45° field of view, image size 1932x1916: 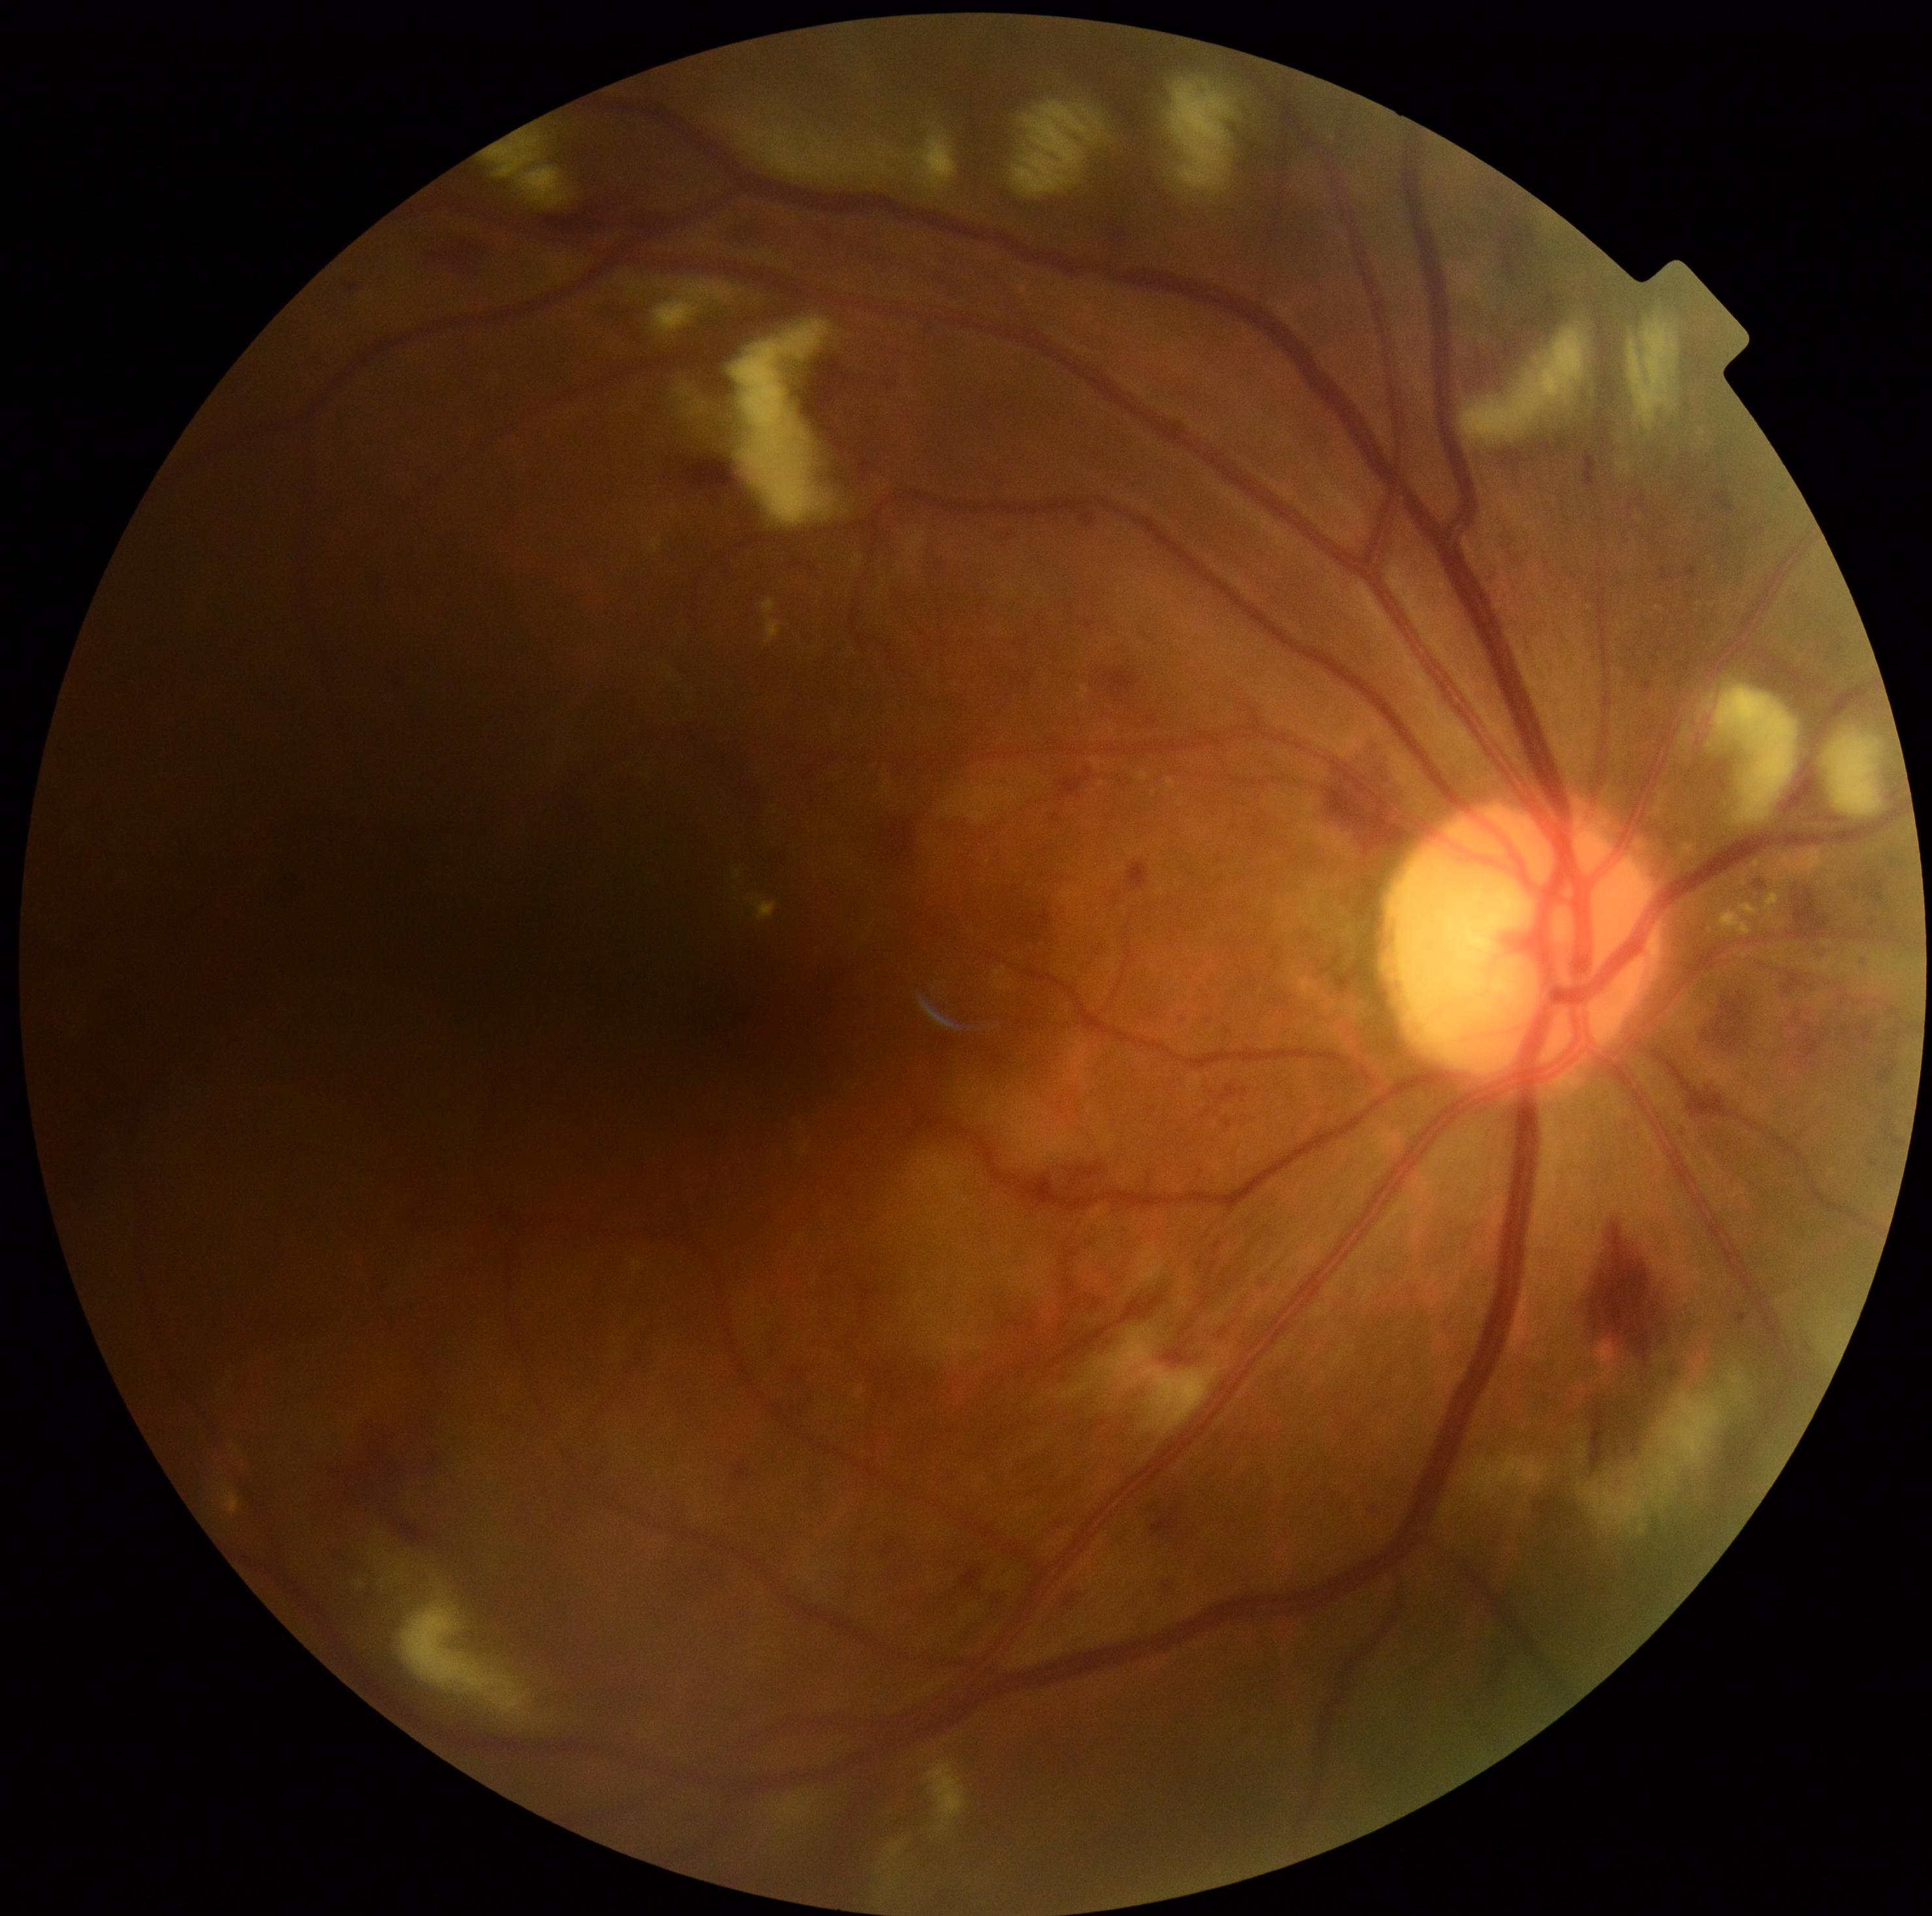
dr_grade: severe NPDR (3)